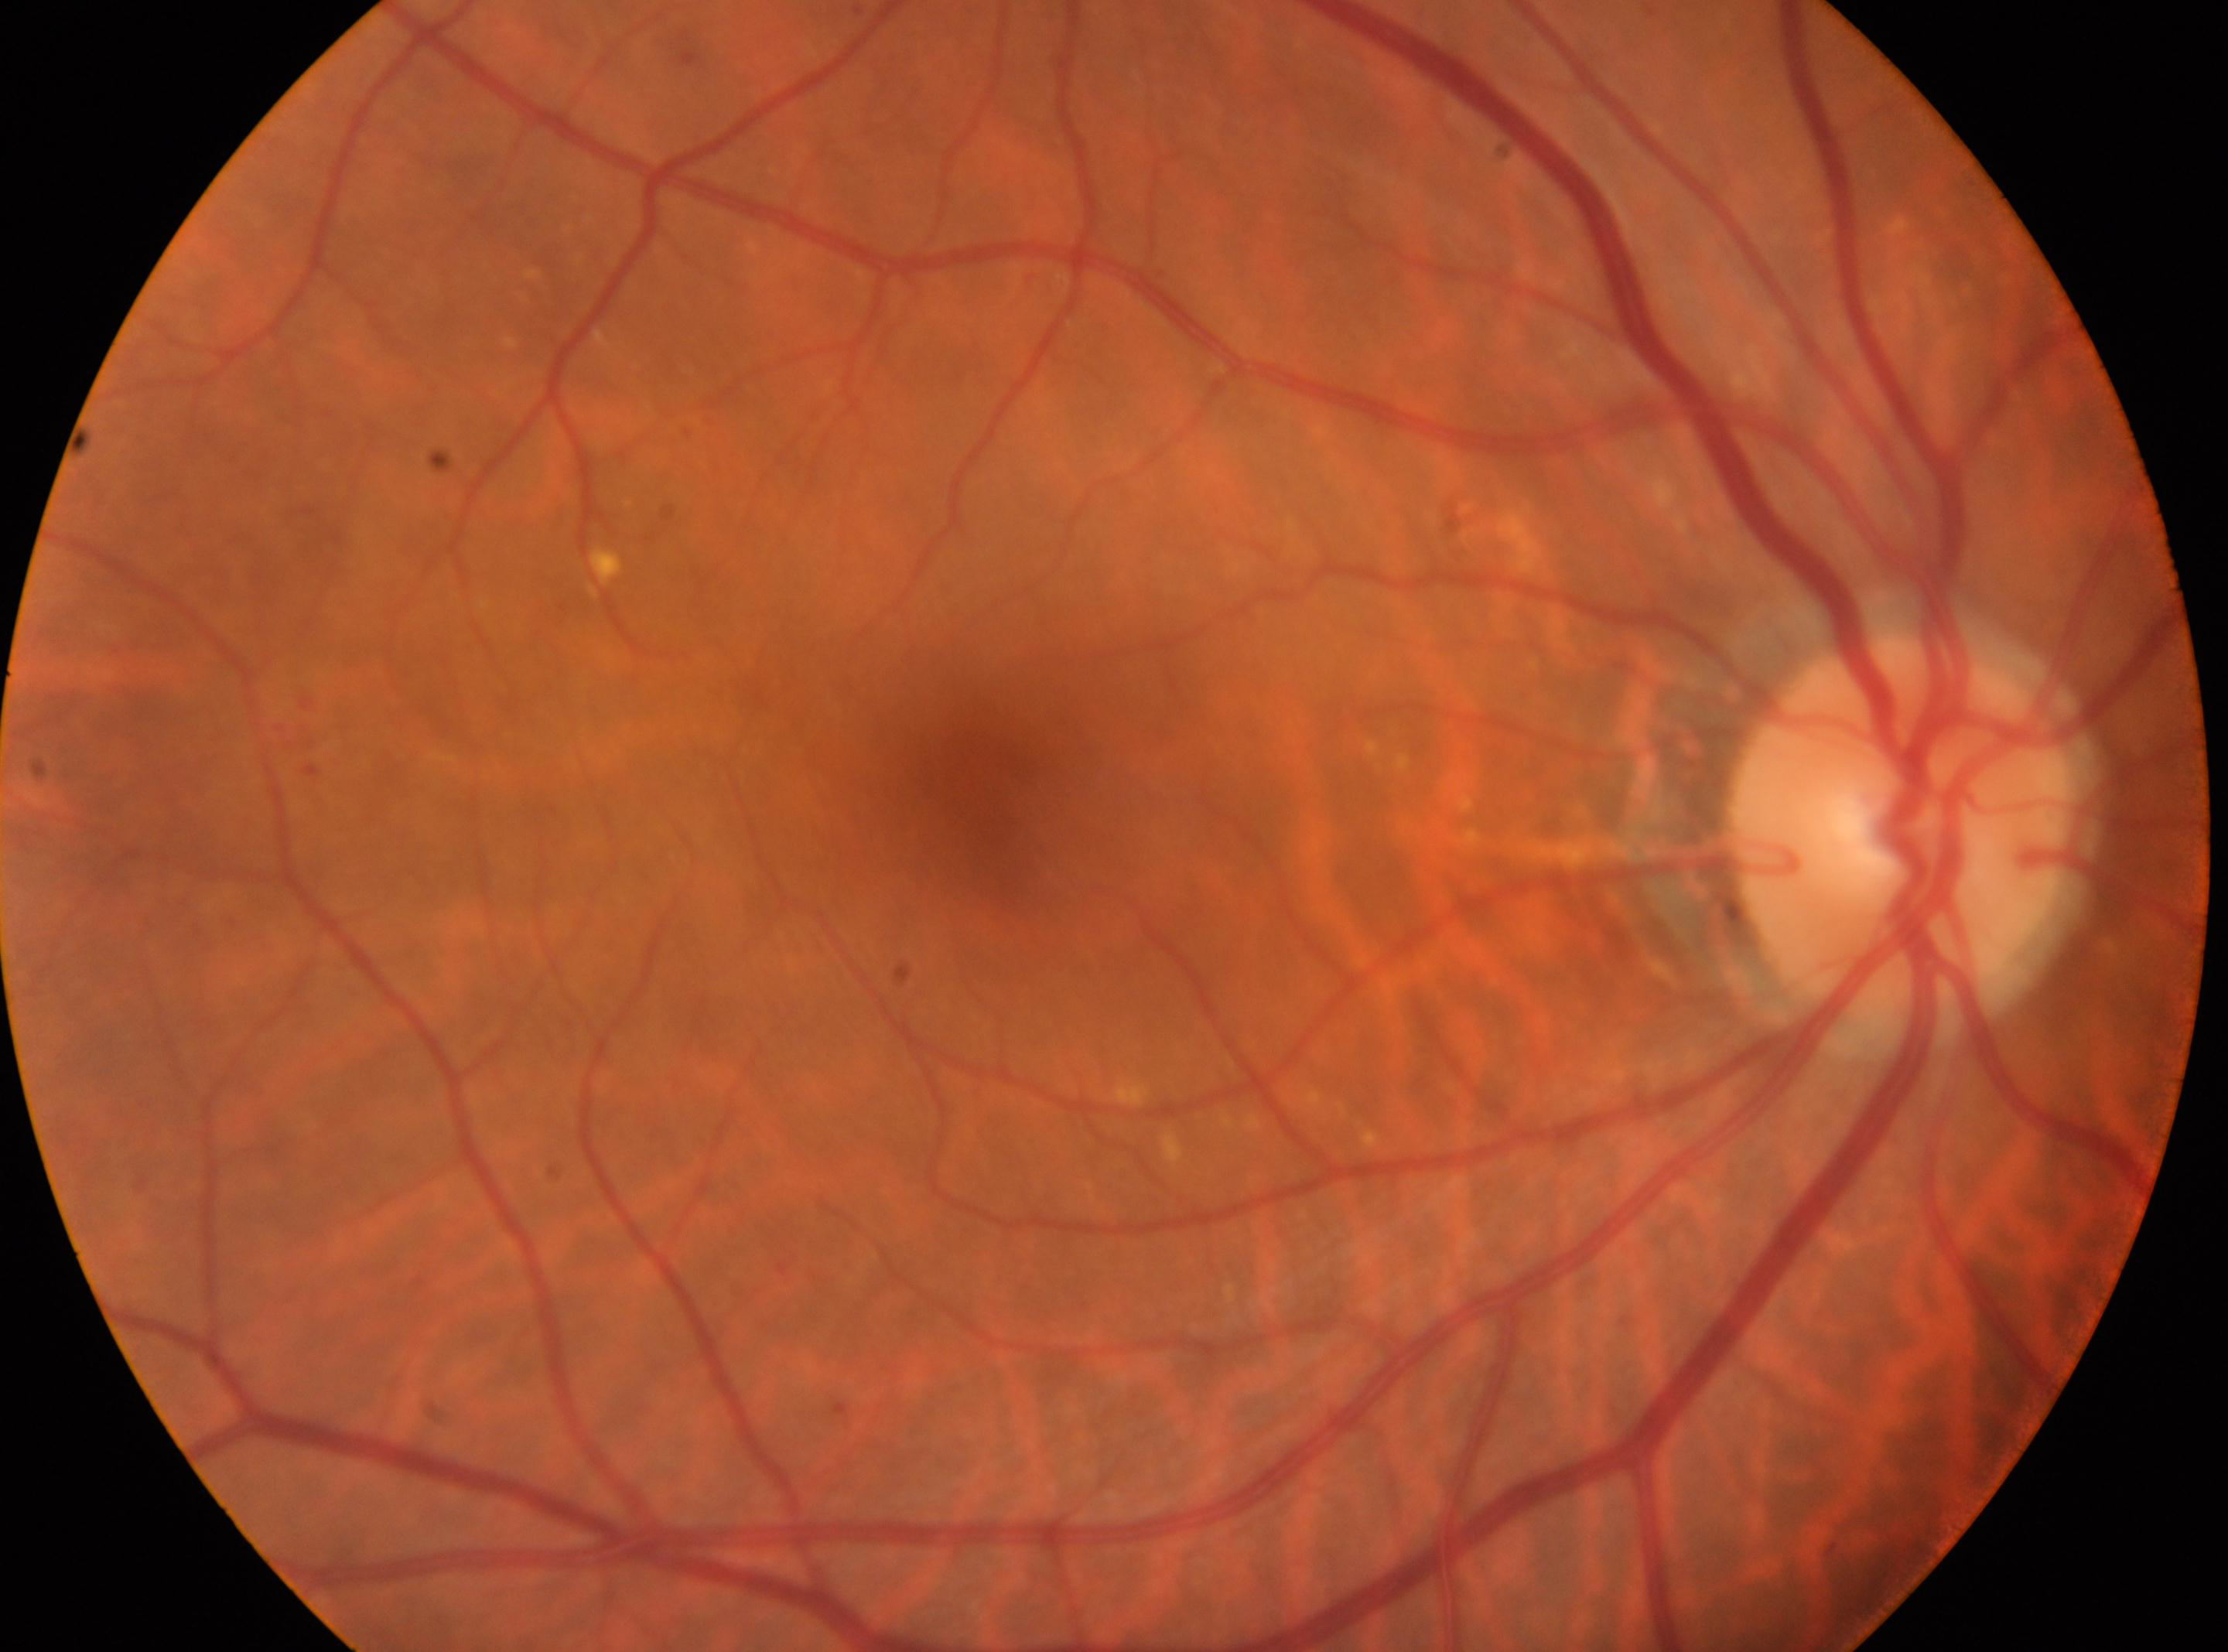 Diabetic retinopathy grade: 2 — more than just microaneurysms but less than severe NPDR.
Optic disk located at [1901, 824].
Imaged eye: right.
The macular center is at [976, 778].